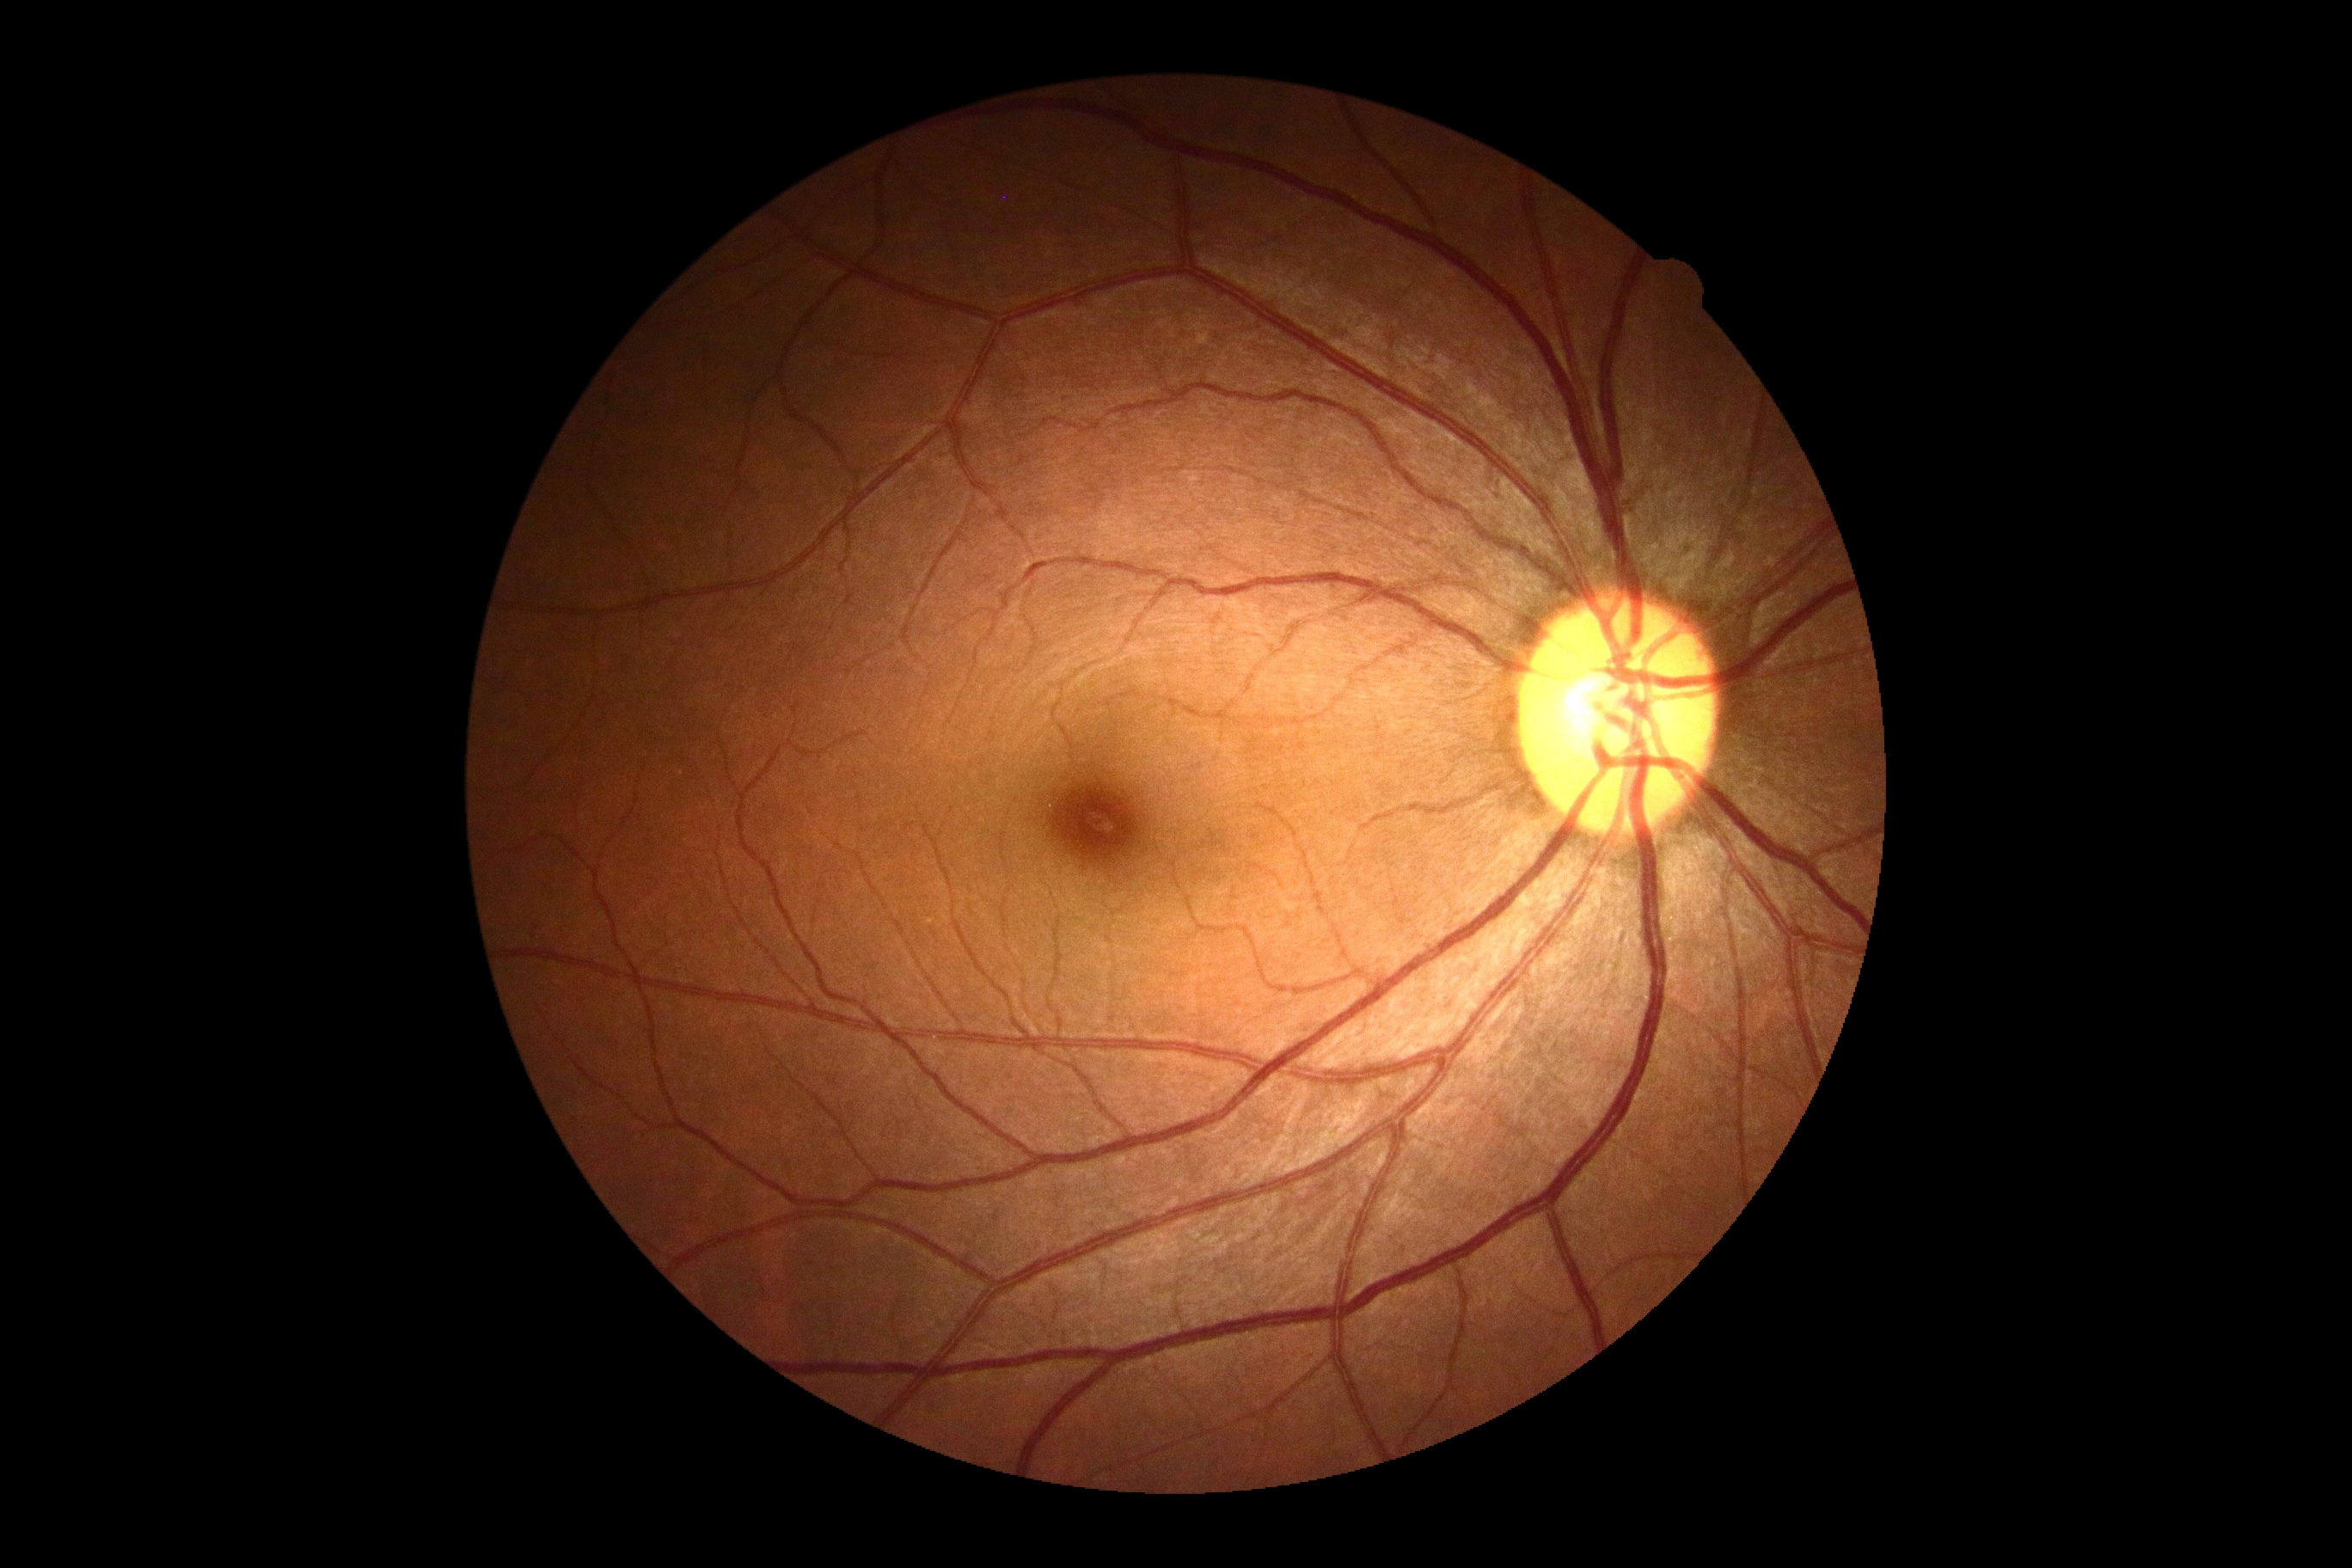 dr_impression: no DR findings
dr_grade: no apparent retinopathy (0)